FOV: 45 degrees:
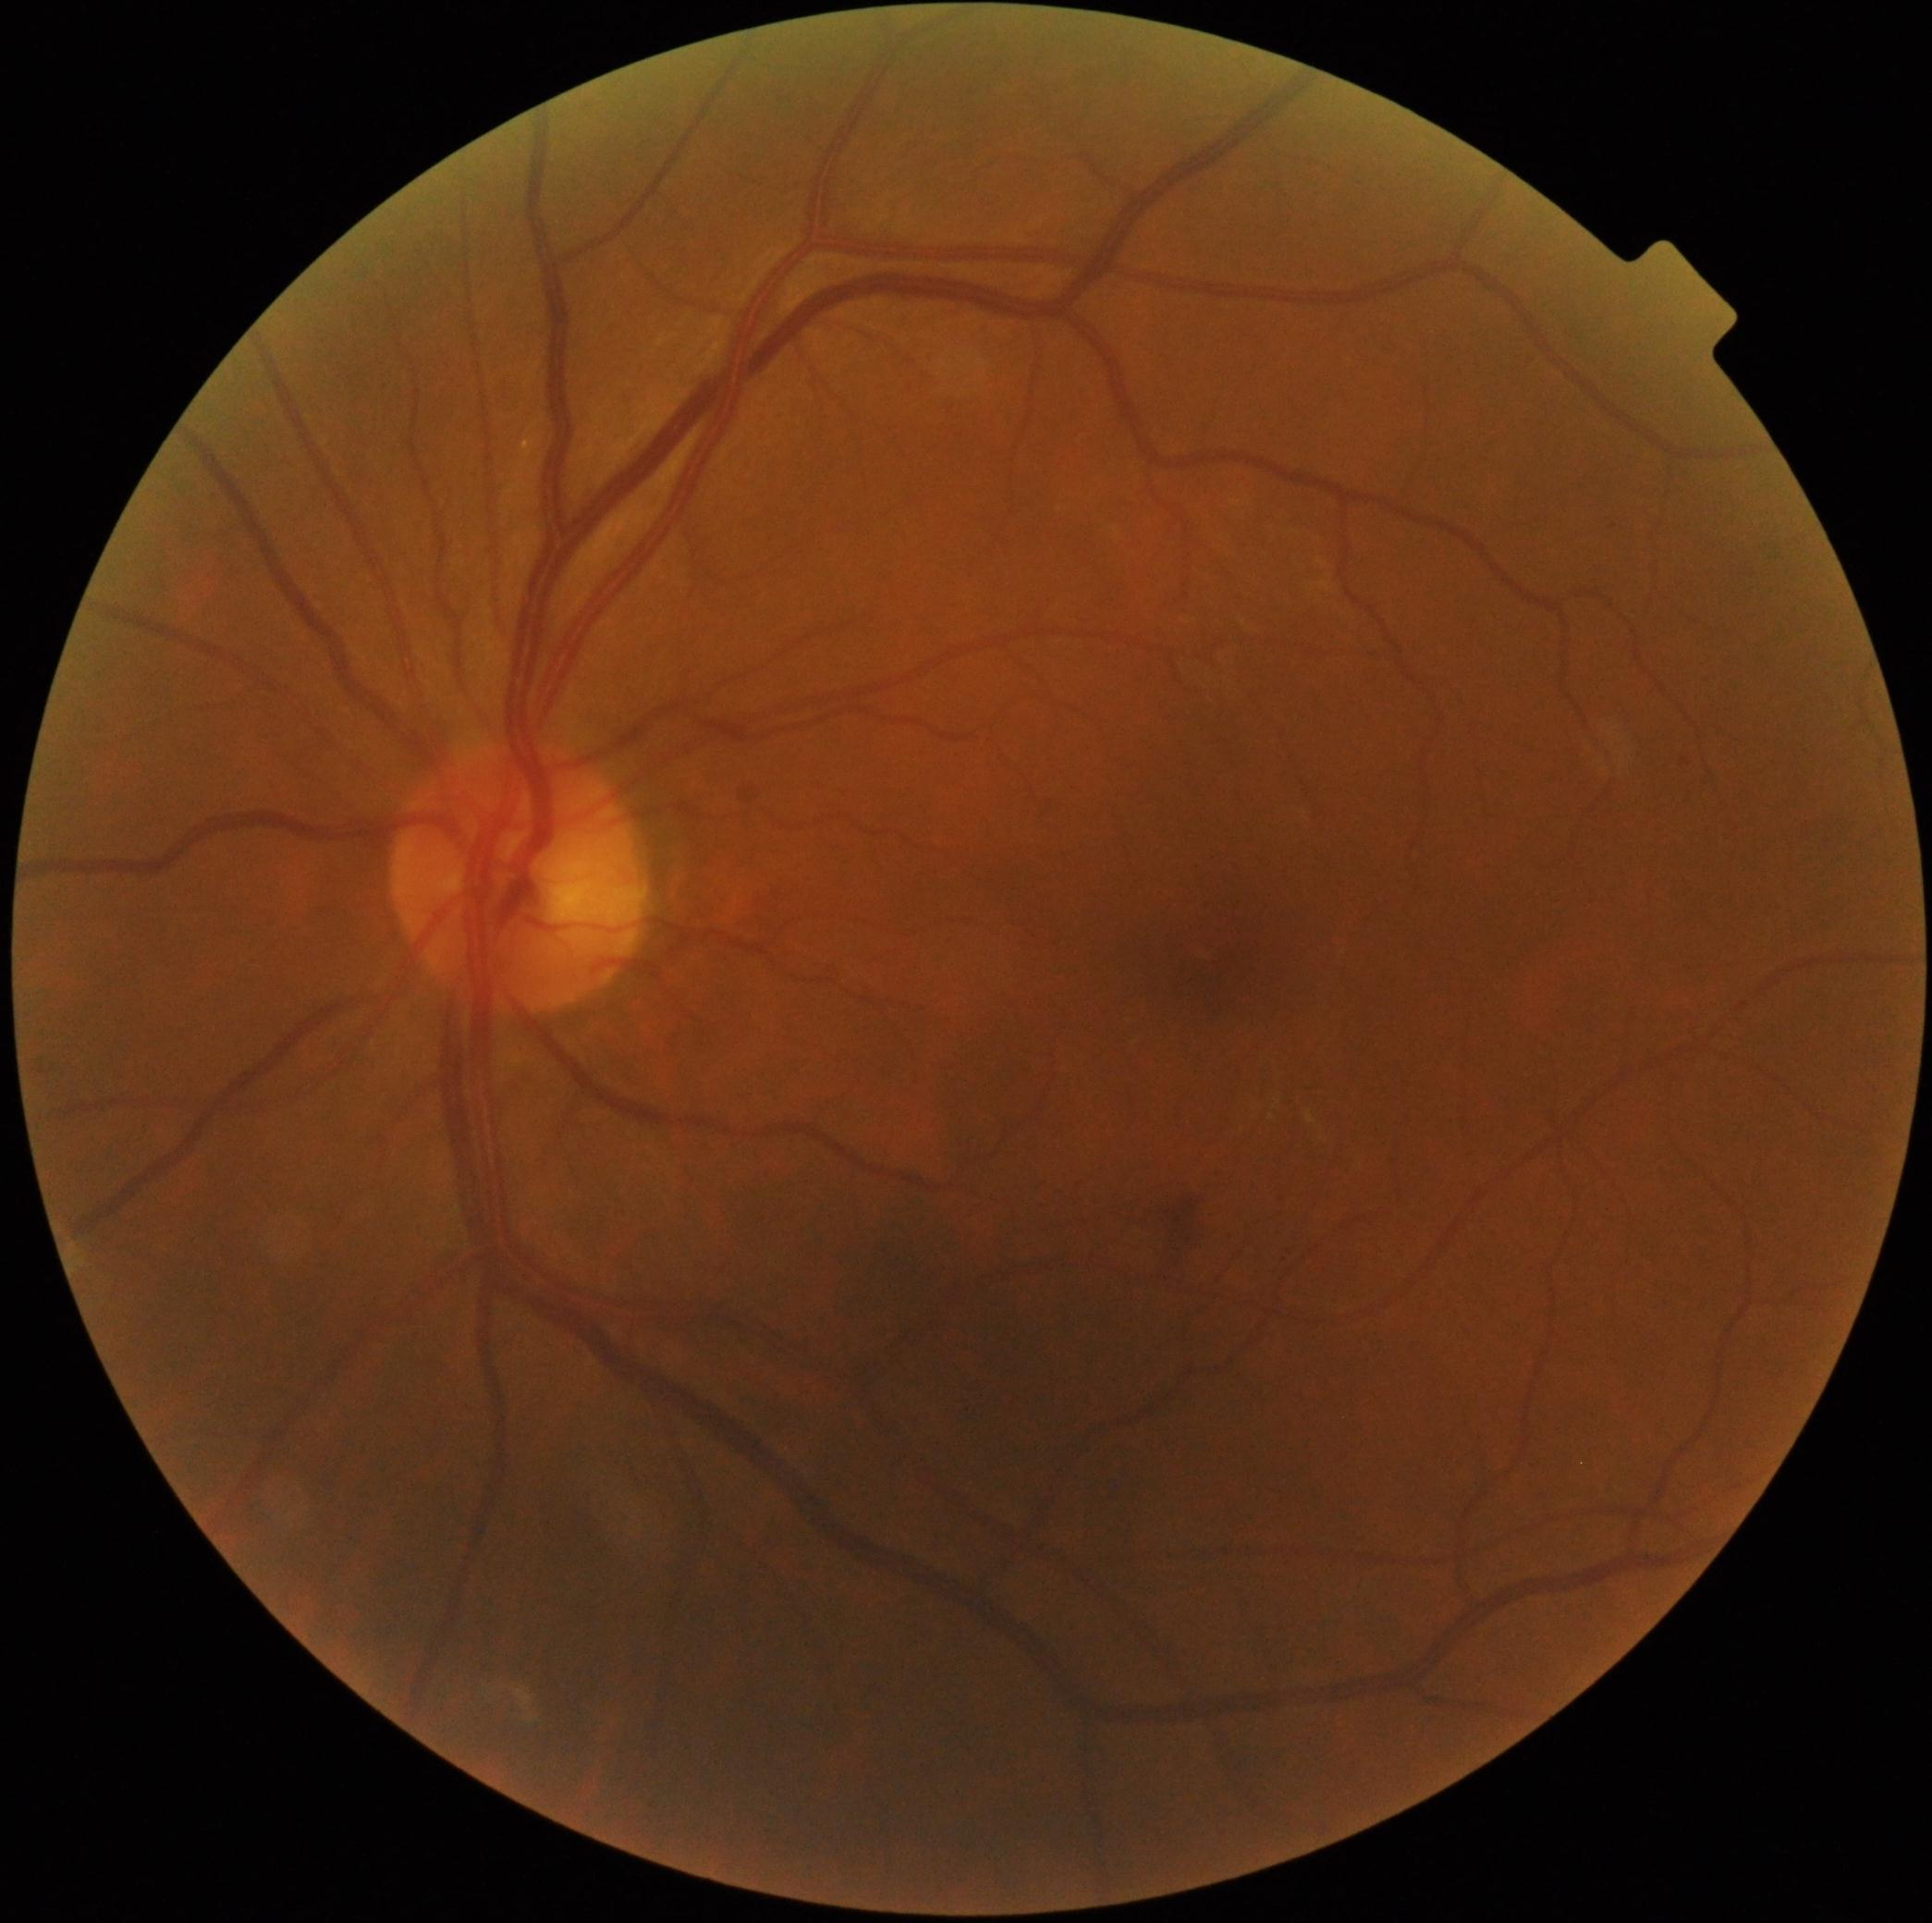

dr_category: non-proliferative diabetic retinopathy
dr_grade: grade 2